Wide-field contact fundus photograph of an infant — 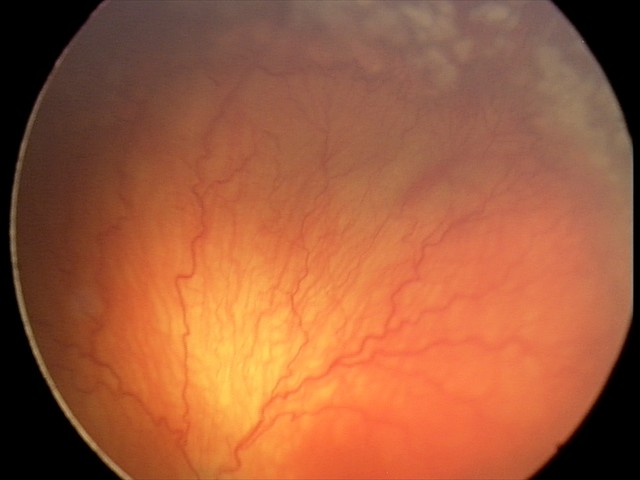

Plus disease present. From an examination with diagnosis of A-ROP (aggressive ROP) — rapidly progressive severe ROP with prominent plus disease, often without classic stage progression.